Pediatric wide-field fundus photograph; camera: Clarity RetCam 3 (130° FOV) — 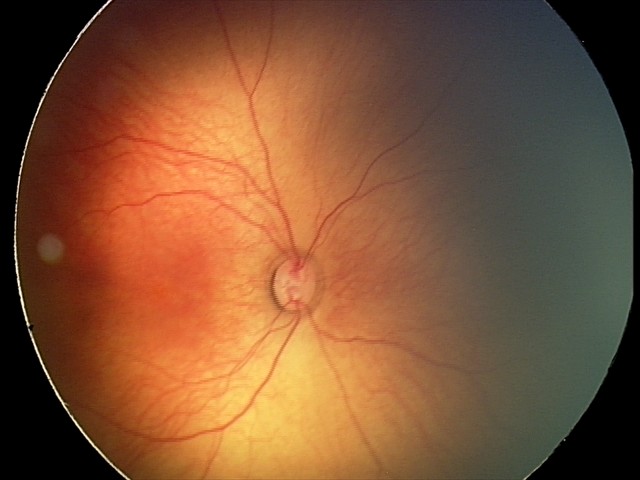 Assessment: normal retinal appearance.